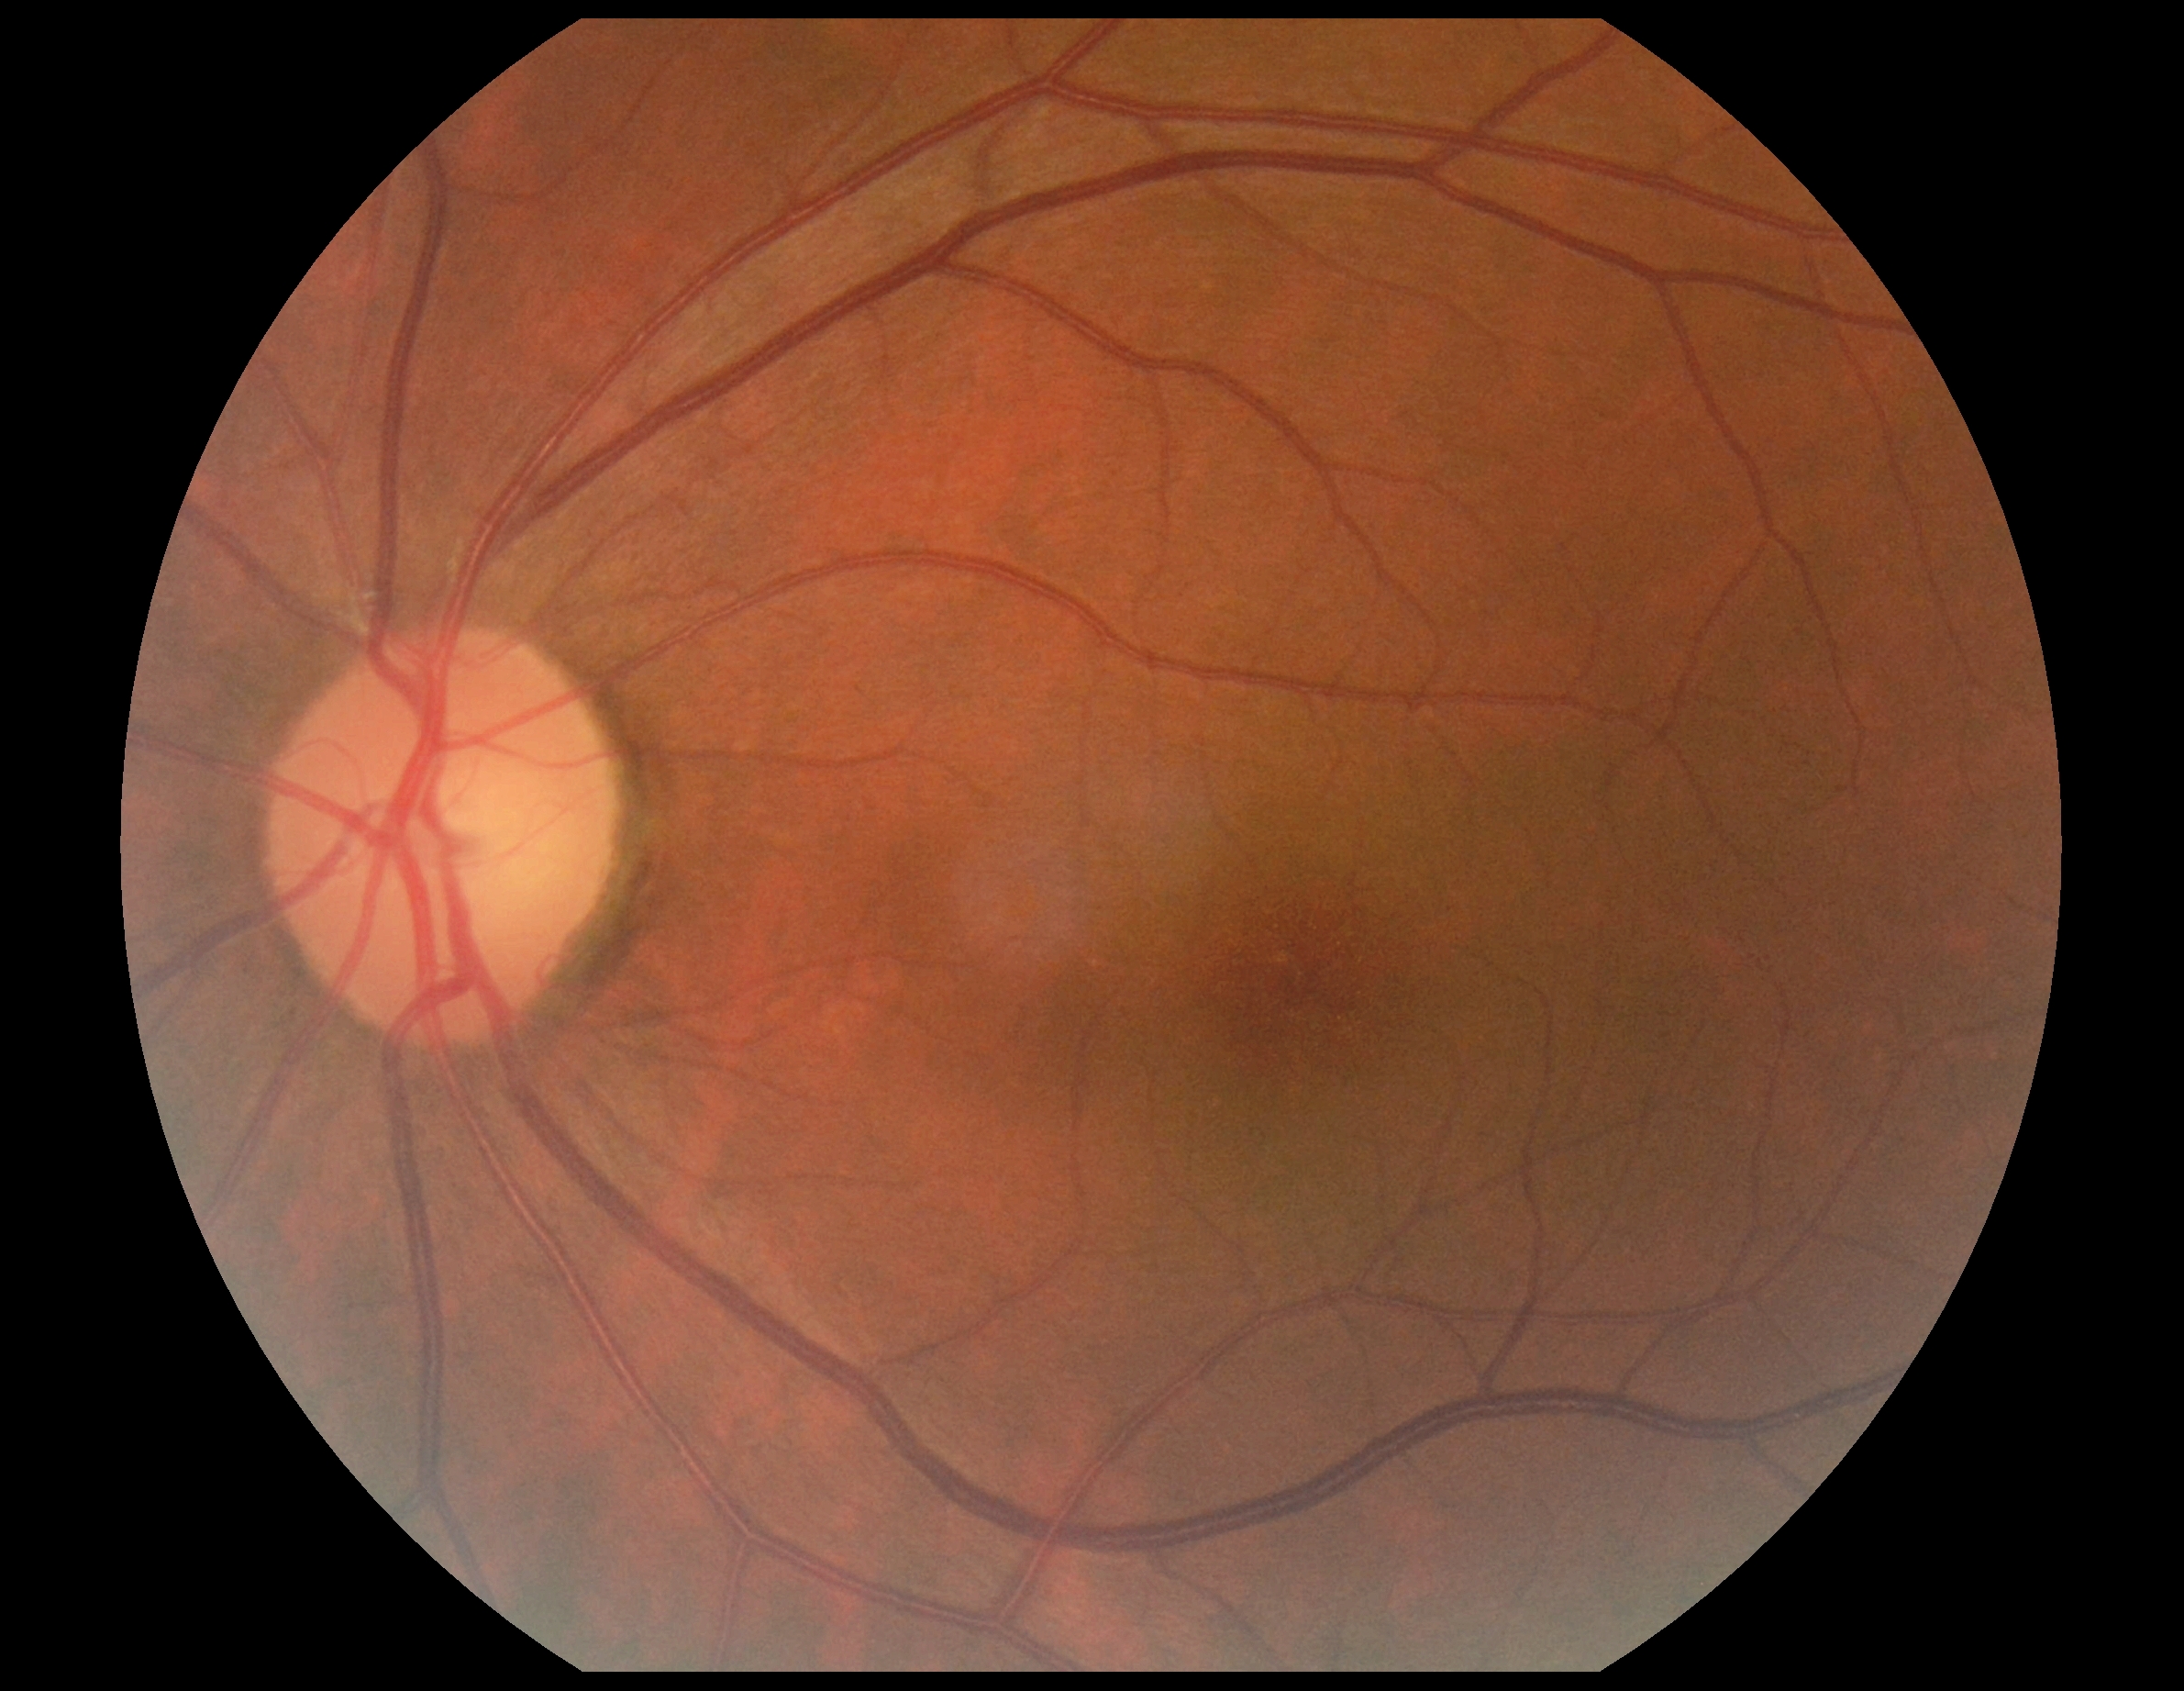 {"dr_grade": "no apparent retinopathy (grade 0)"}